FOV: 45 degrees — 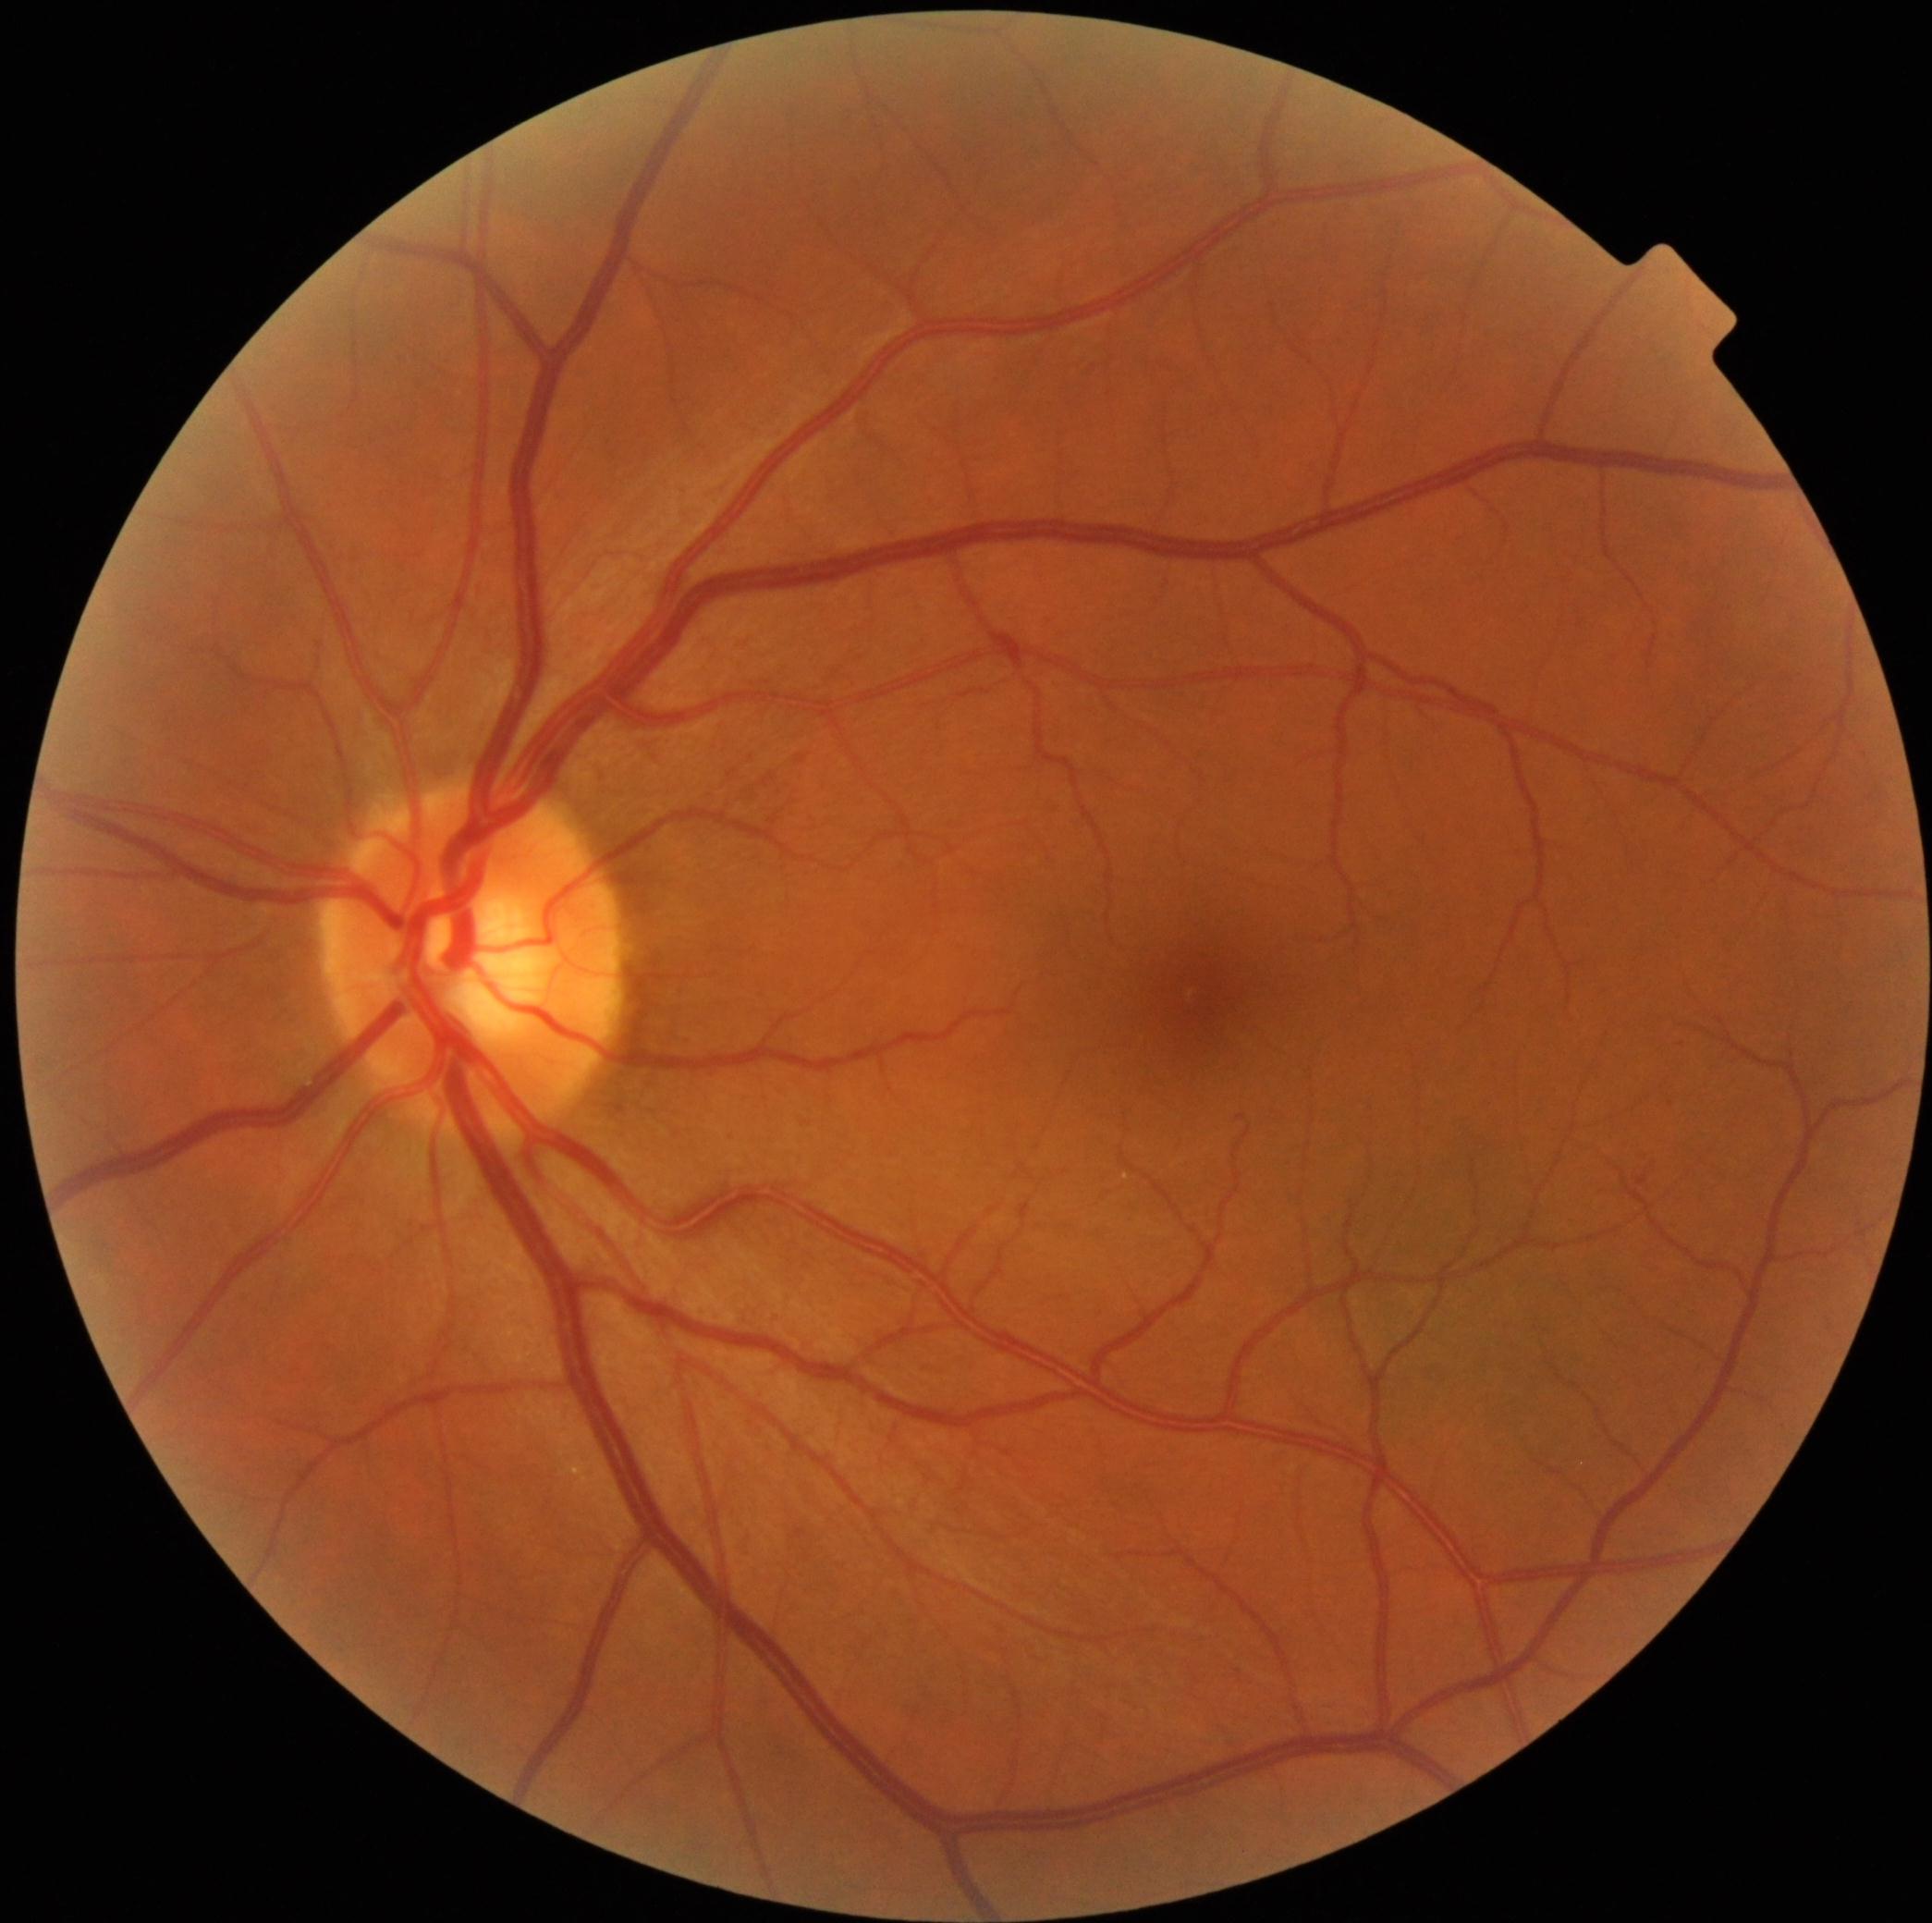

Findings:
- DR stage — grade 0 (no apparent retinopathy)